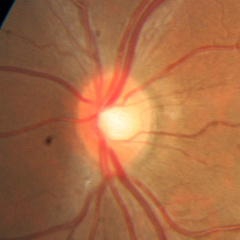
Fundus image with findings of no glaucomatous changes.